Pediatric retinal photograph (wide-field); 640 x 480 pixels — 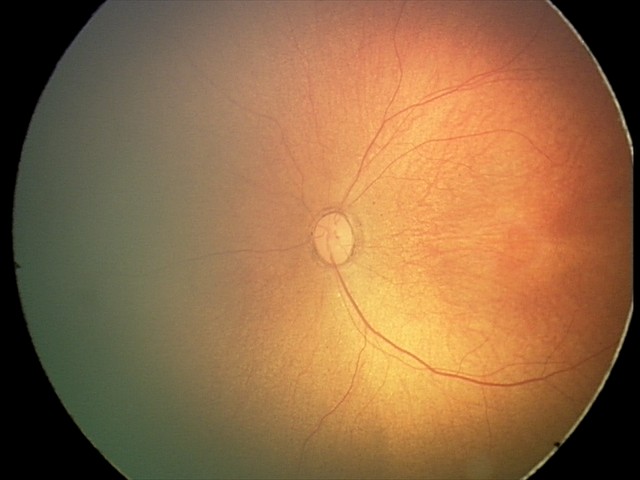 Screening examination diagnosed as physiological.